Non-mydriatic acquisition.
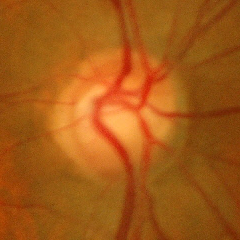 No signs of glaucoma.